Nonmydriatic fundus photograph, 848x848, Davis DR grading.
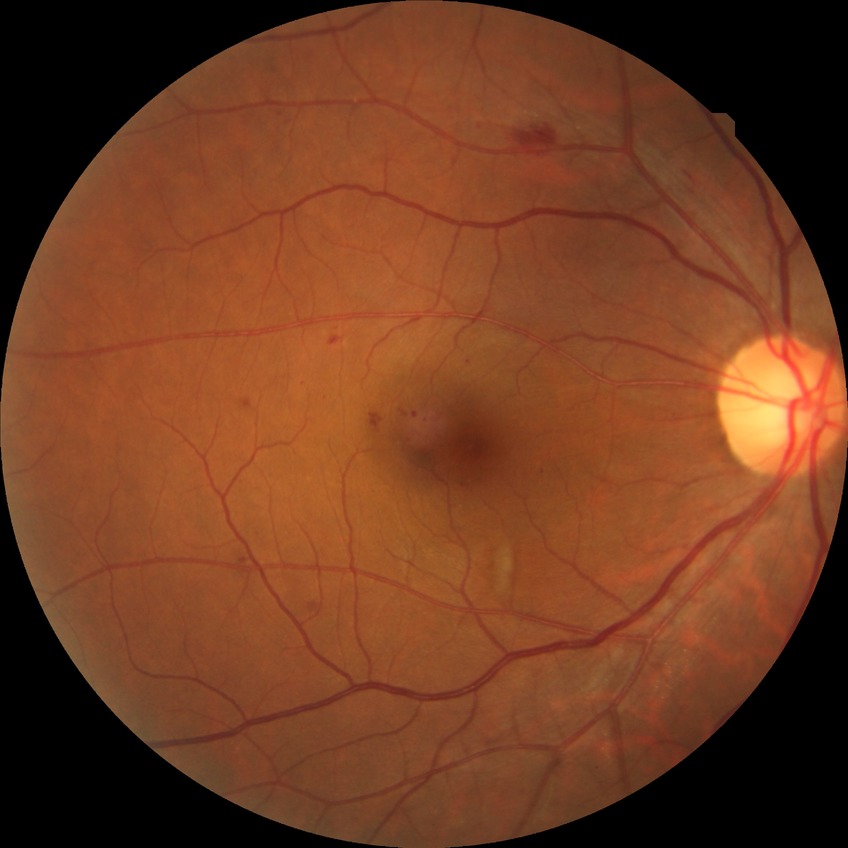 DR grade is SDR.